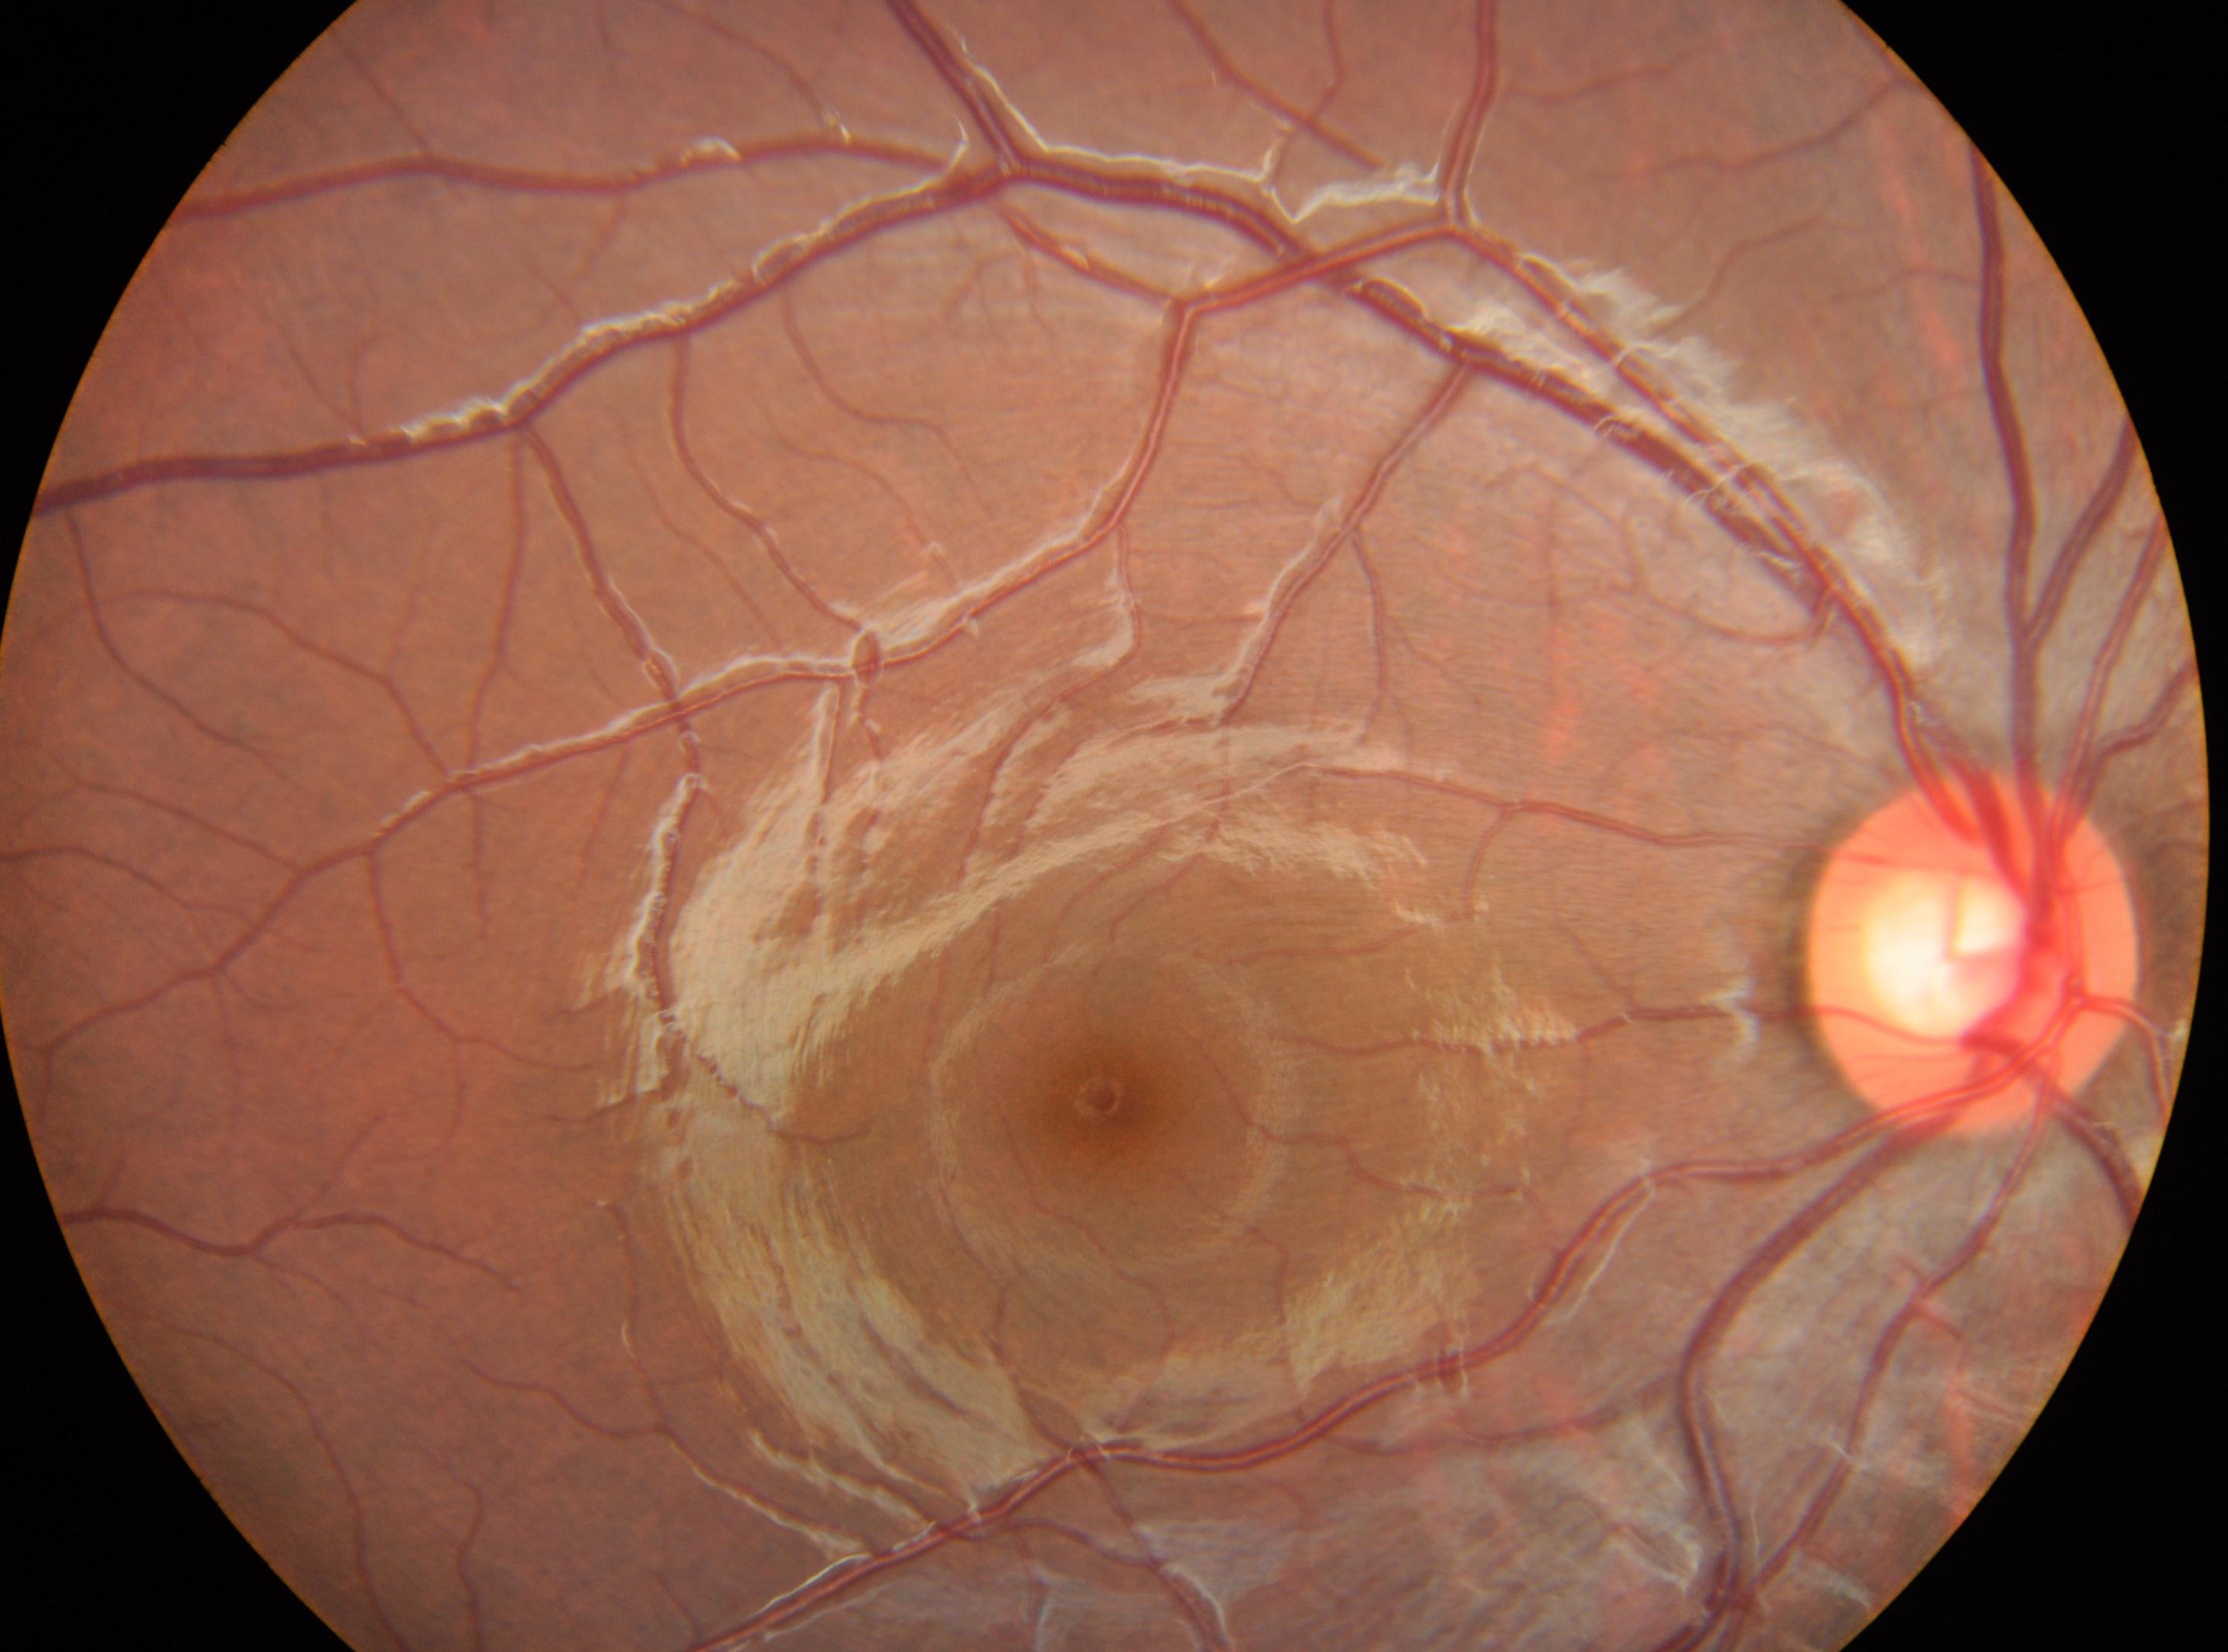

optic disc center: 1973px, 953px; foveal center: 1112px, 1100px; right eye; DR stage: grade 0 — no visible signs of diabetic retinopathy.